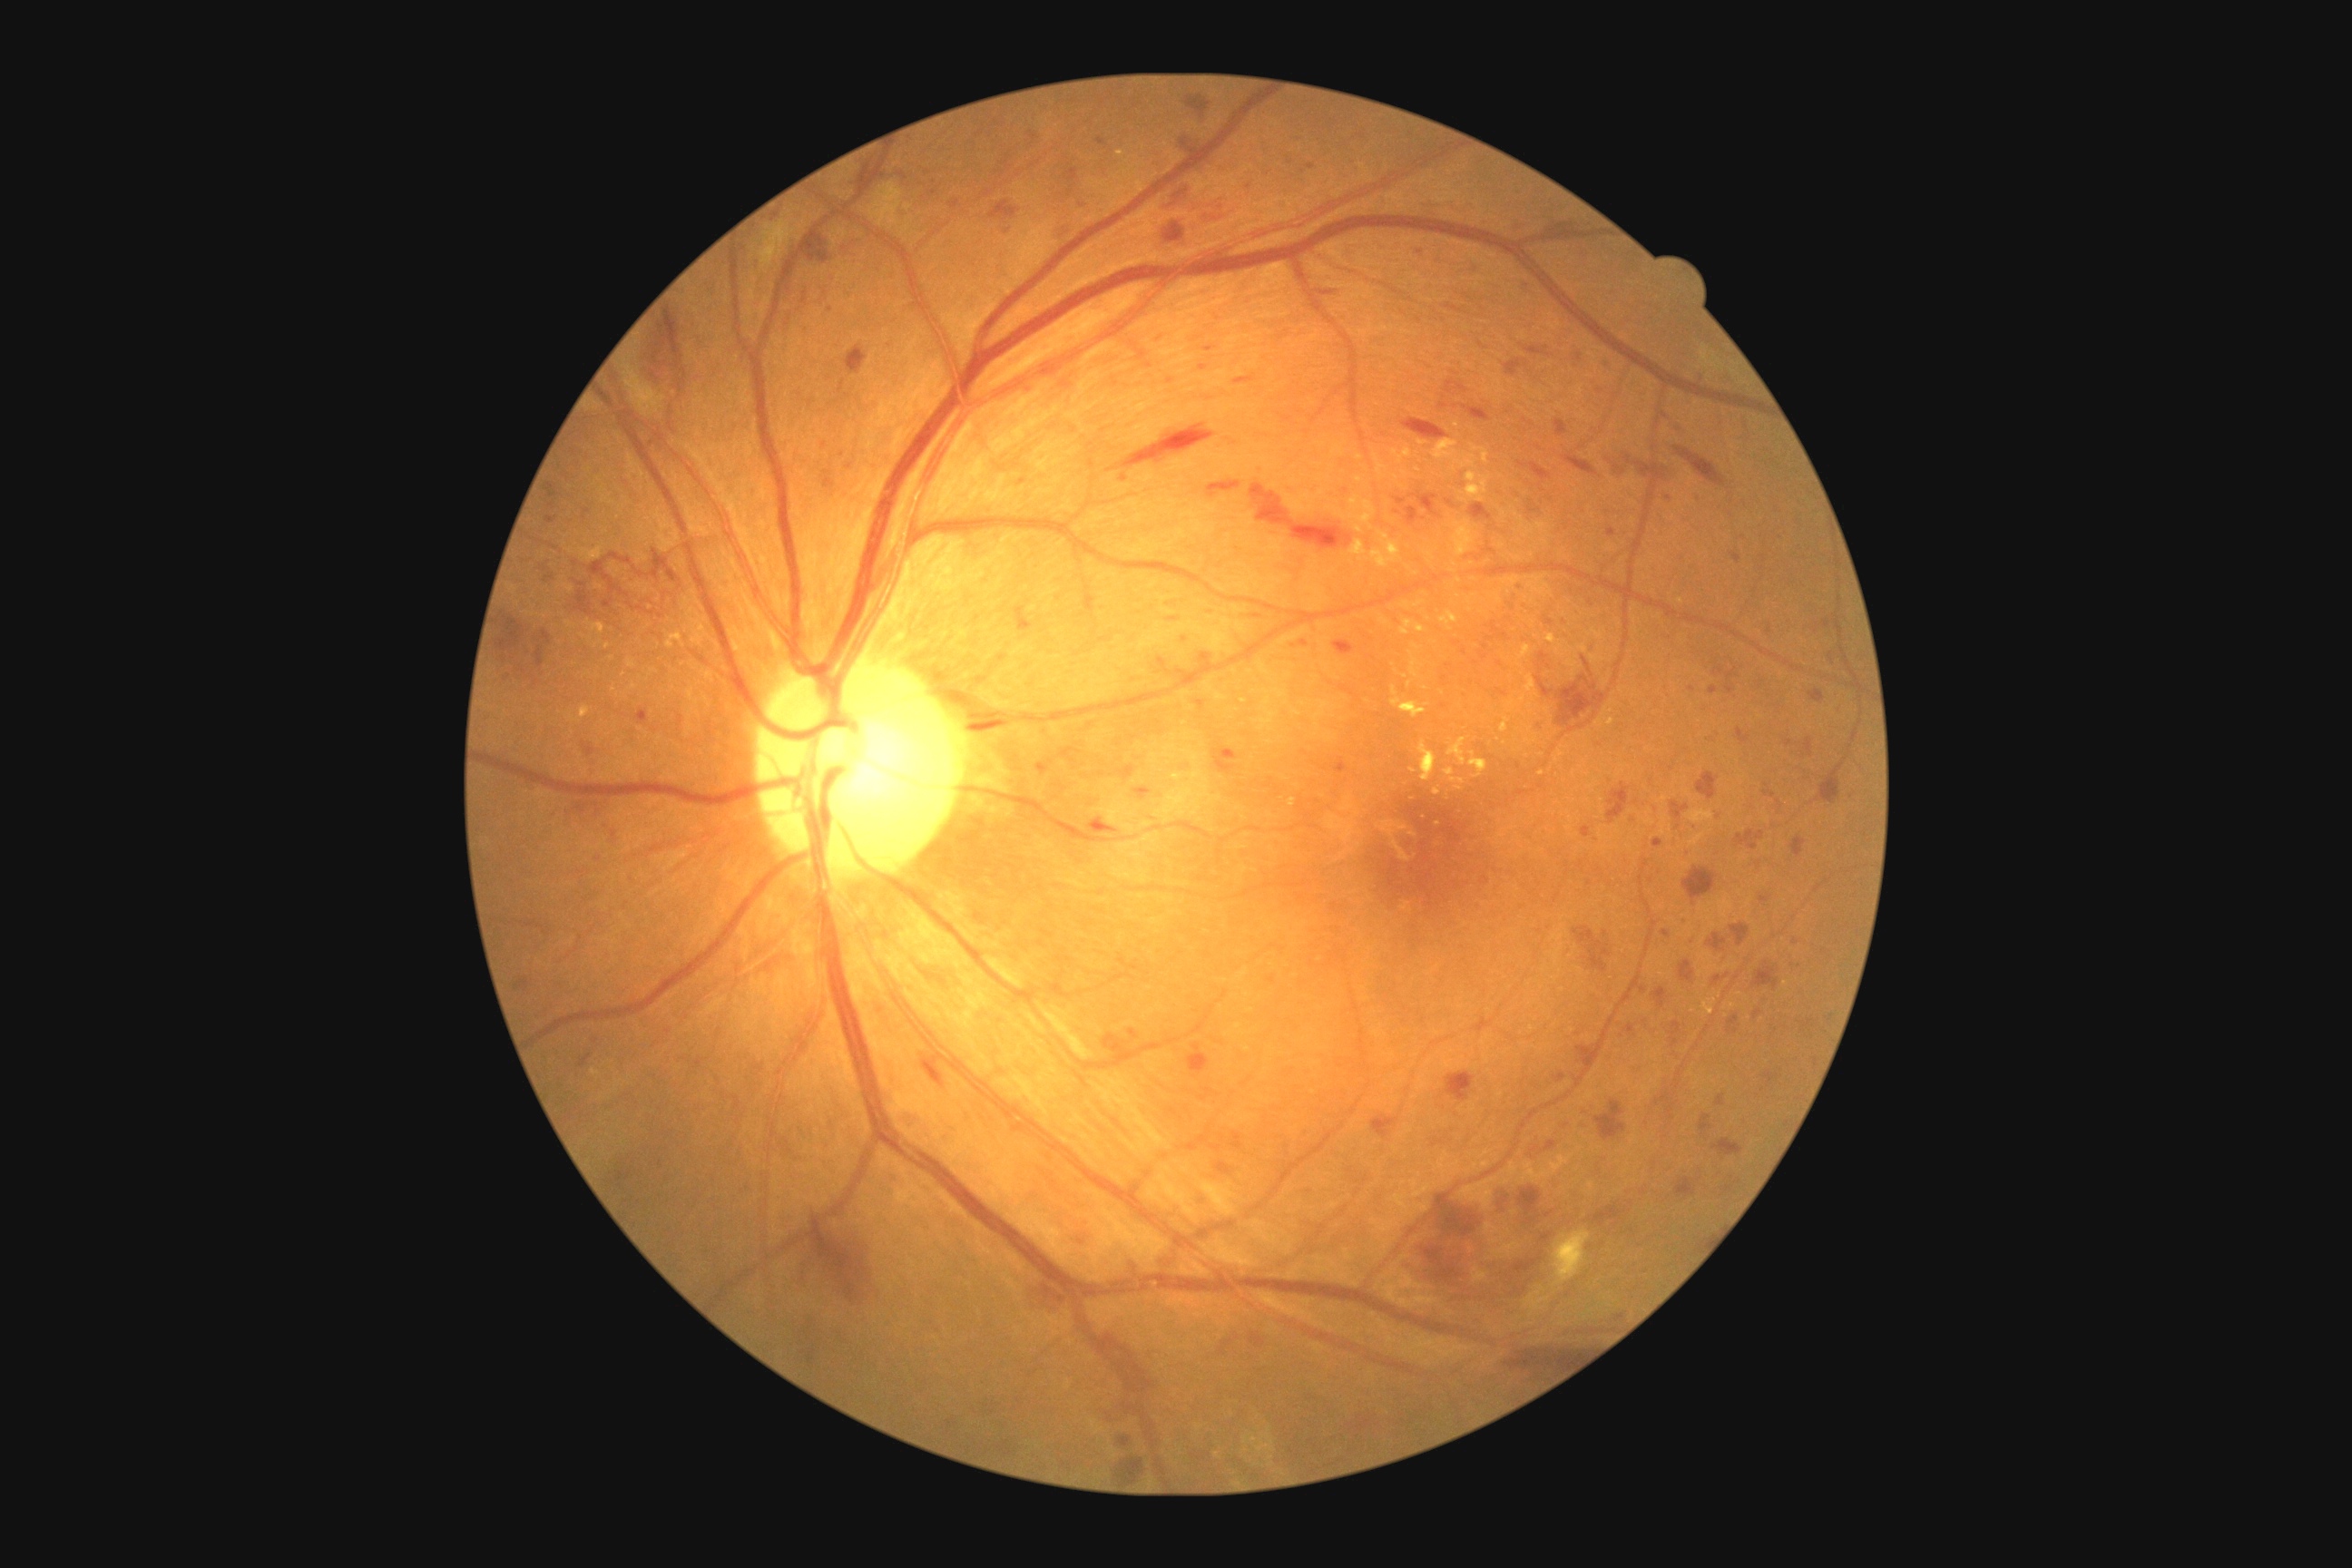

{"partial":true,"dr_grade":3,"lesions":{"he":[[514,977,529,992],[1502,1342,1589,1367],[576,591,593,616],[847,346,868,375],[1493,1188,1511,1215],[1152,335,1162,340],[1250,1333,1266,1348],[1032,1286,1068,1313],[1190,210,1231,226],[1763,783,1776,799],[1157,658,1171,676],[1317,289,1340,295],[1130,787,1150,792],[612,830,618,839],[928,1059,943,1083],[542,631,553,643],[1068,186,1075,197],[1652,986,1667,1008],[1409,493,1440,518]],"he_small":[[1578,611]]}}